Infant wide-field retinal image; 1240 by 1240 pixels.
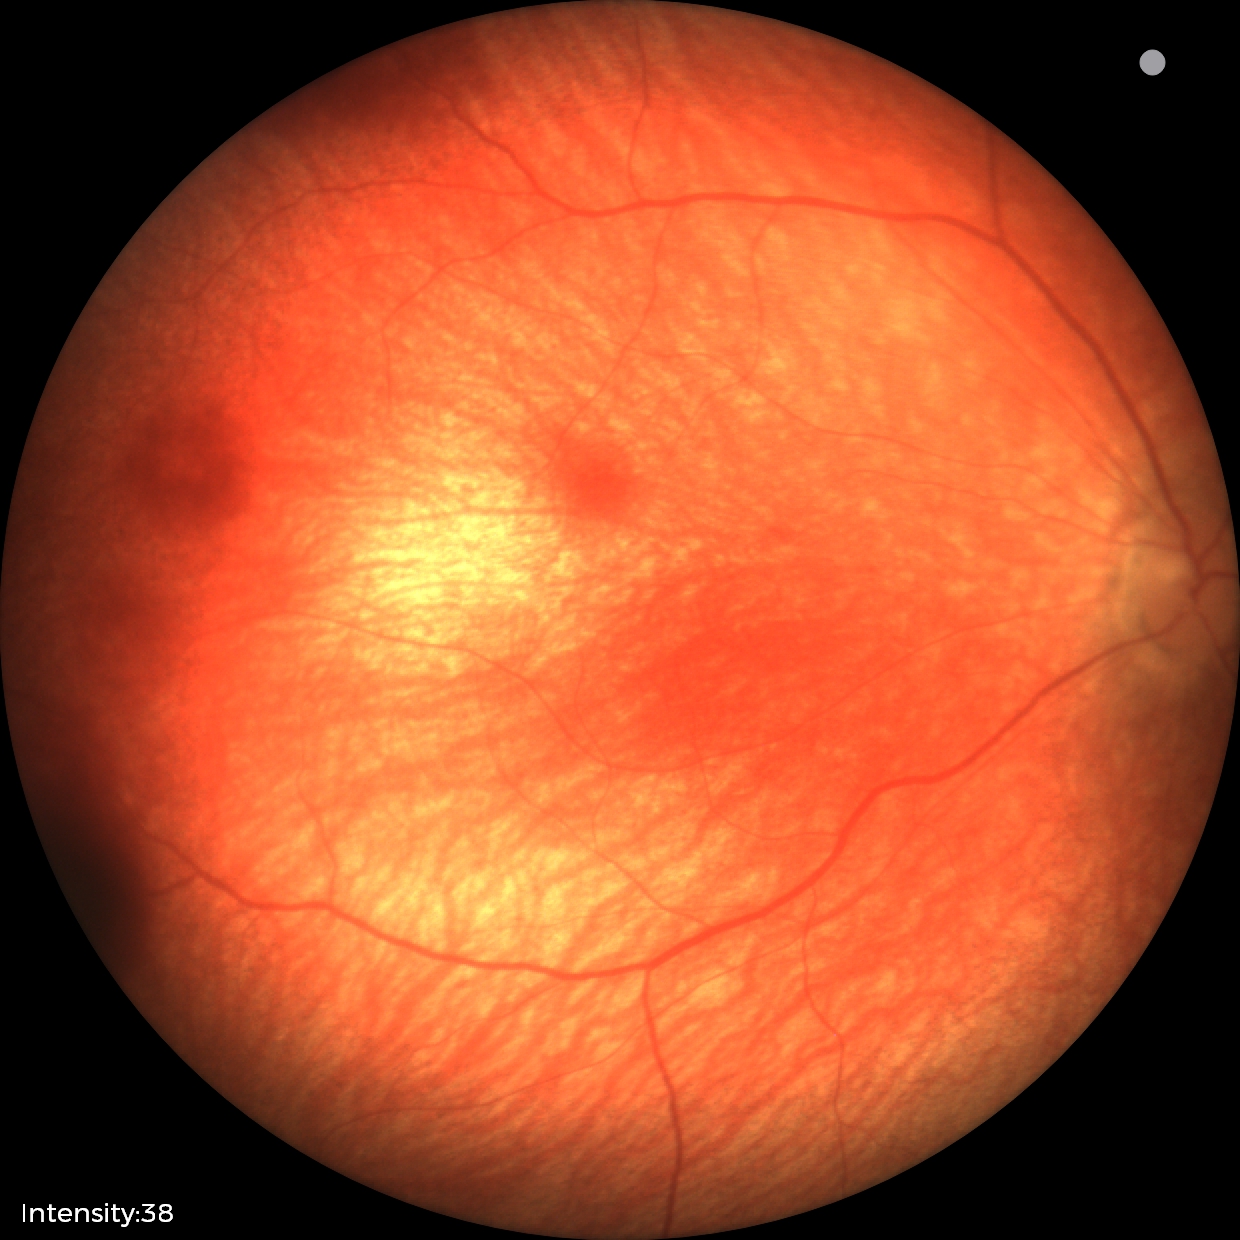

Assessment = retinal hemorrhages.